Graded on the modified Davis scale
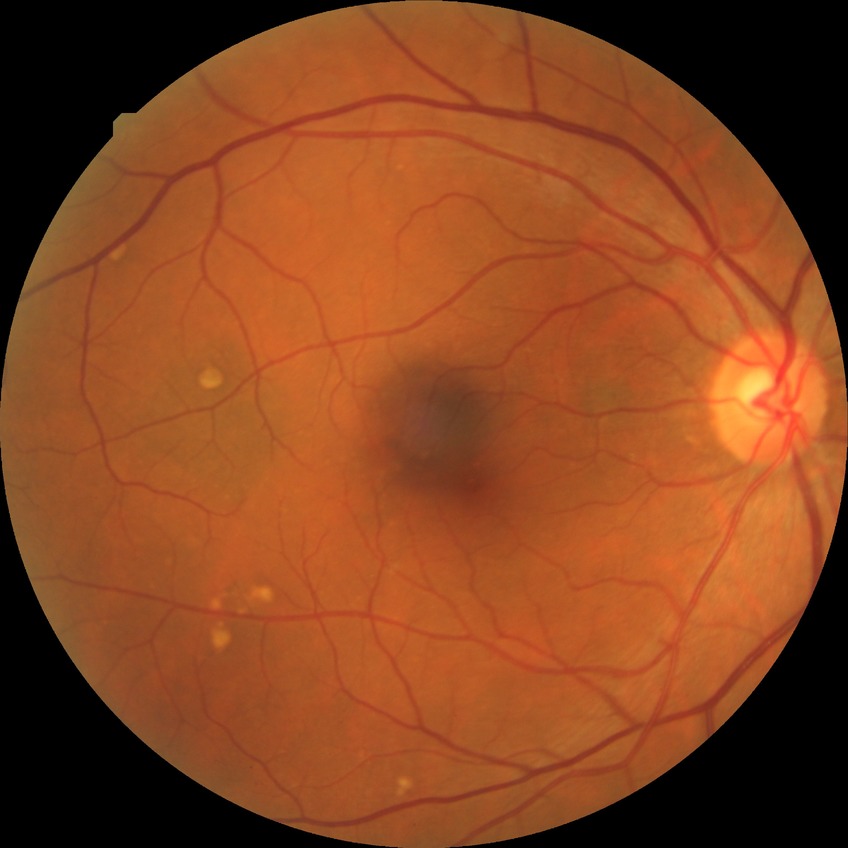
DR grade: SDR